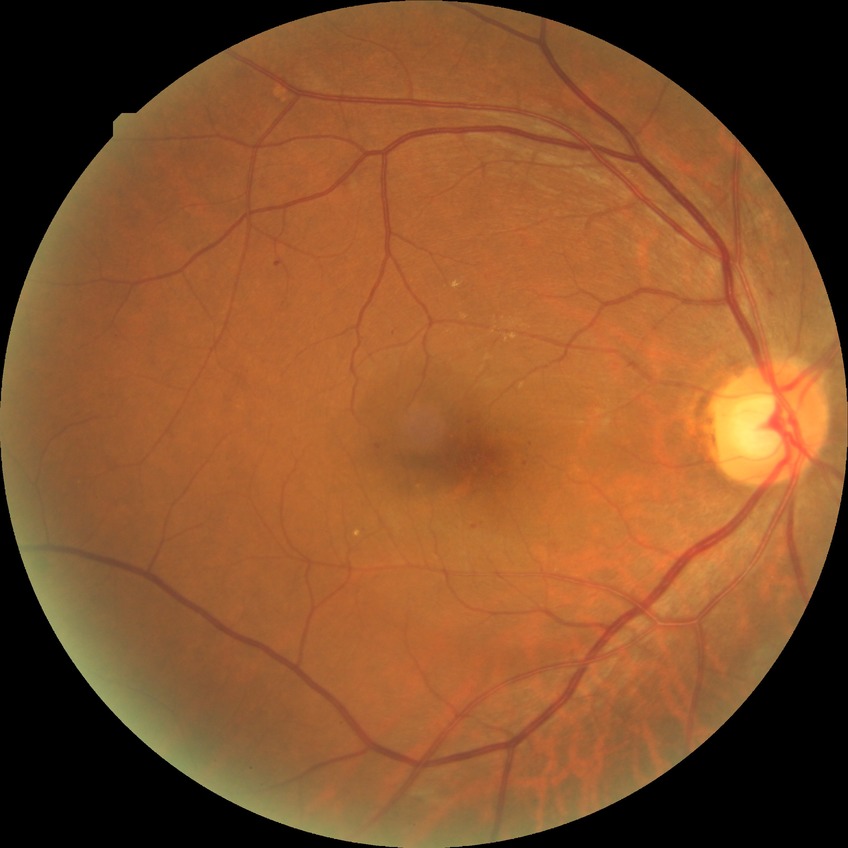

Diabetic retinopathy (DR) is SDR (simple diabetic retinopathy).